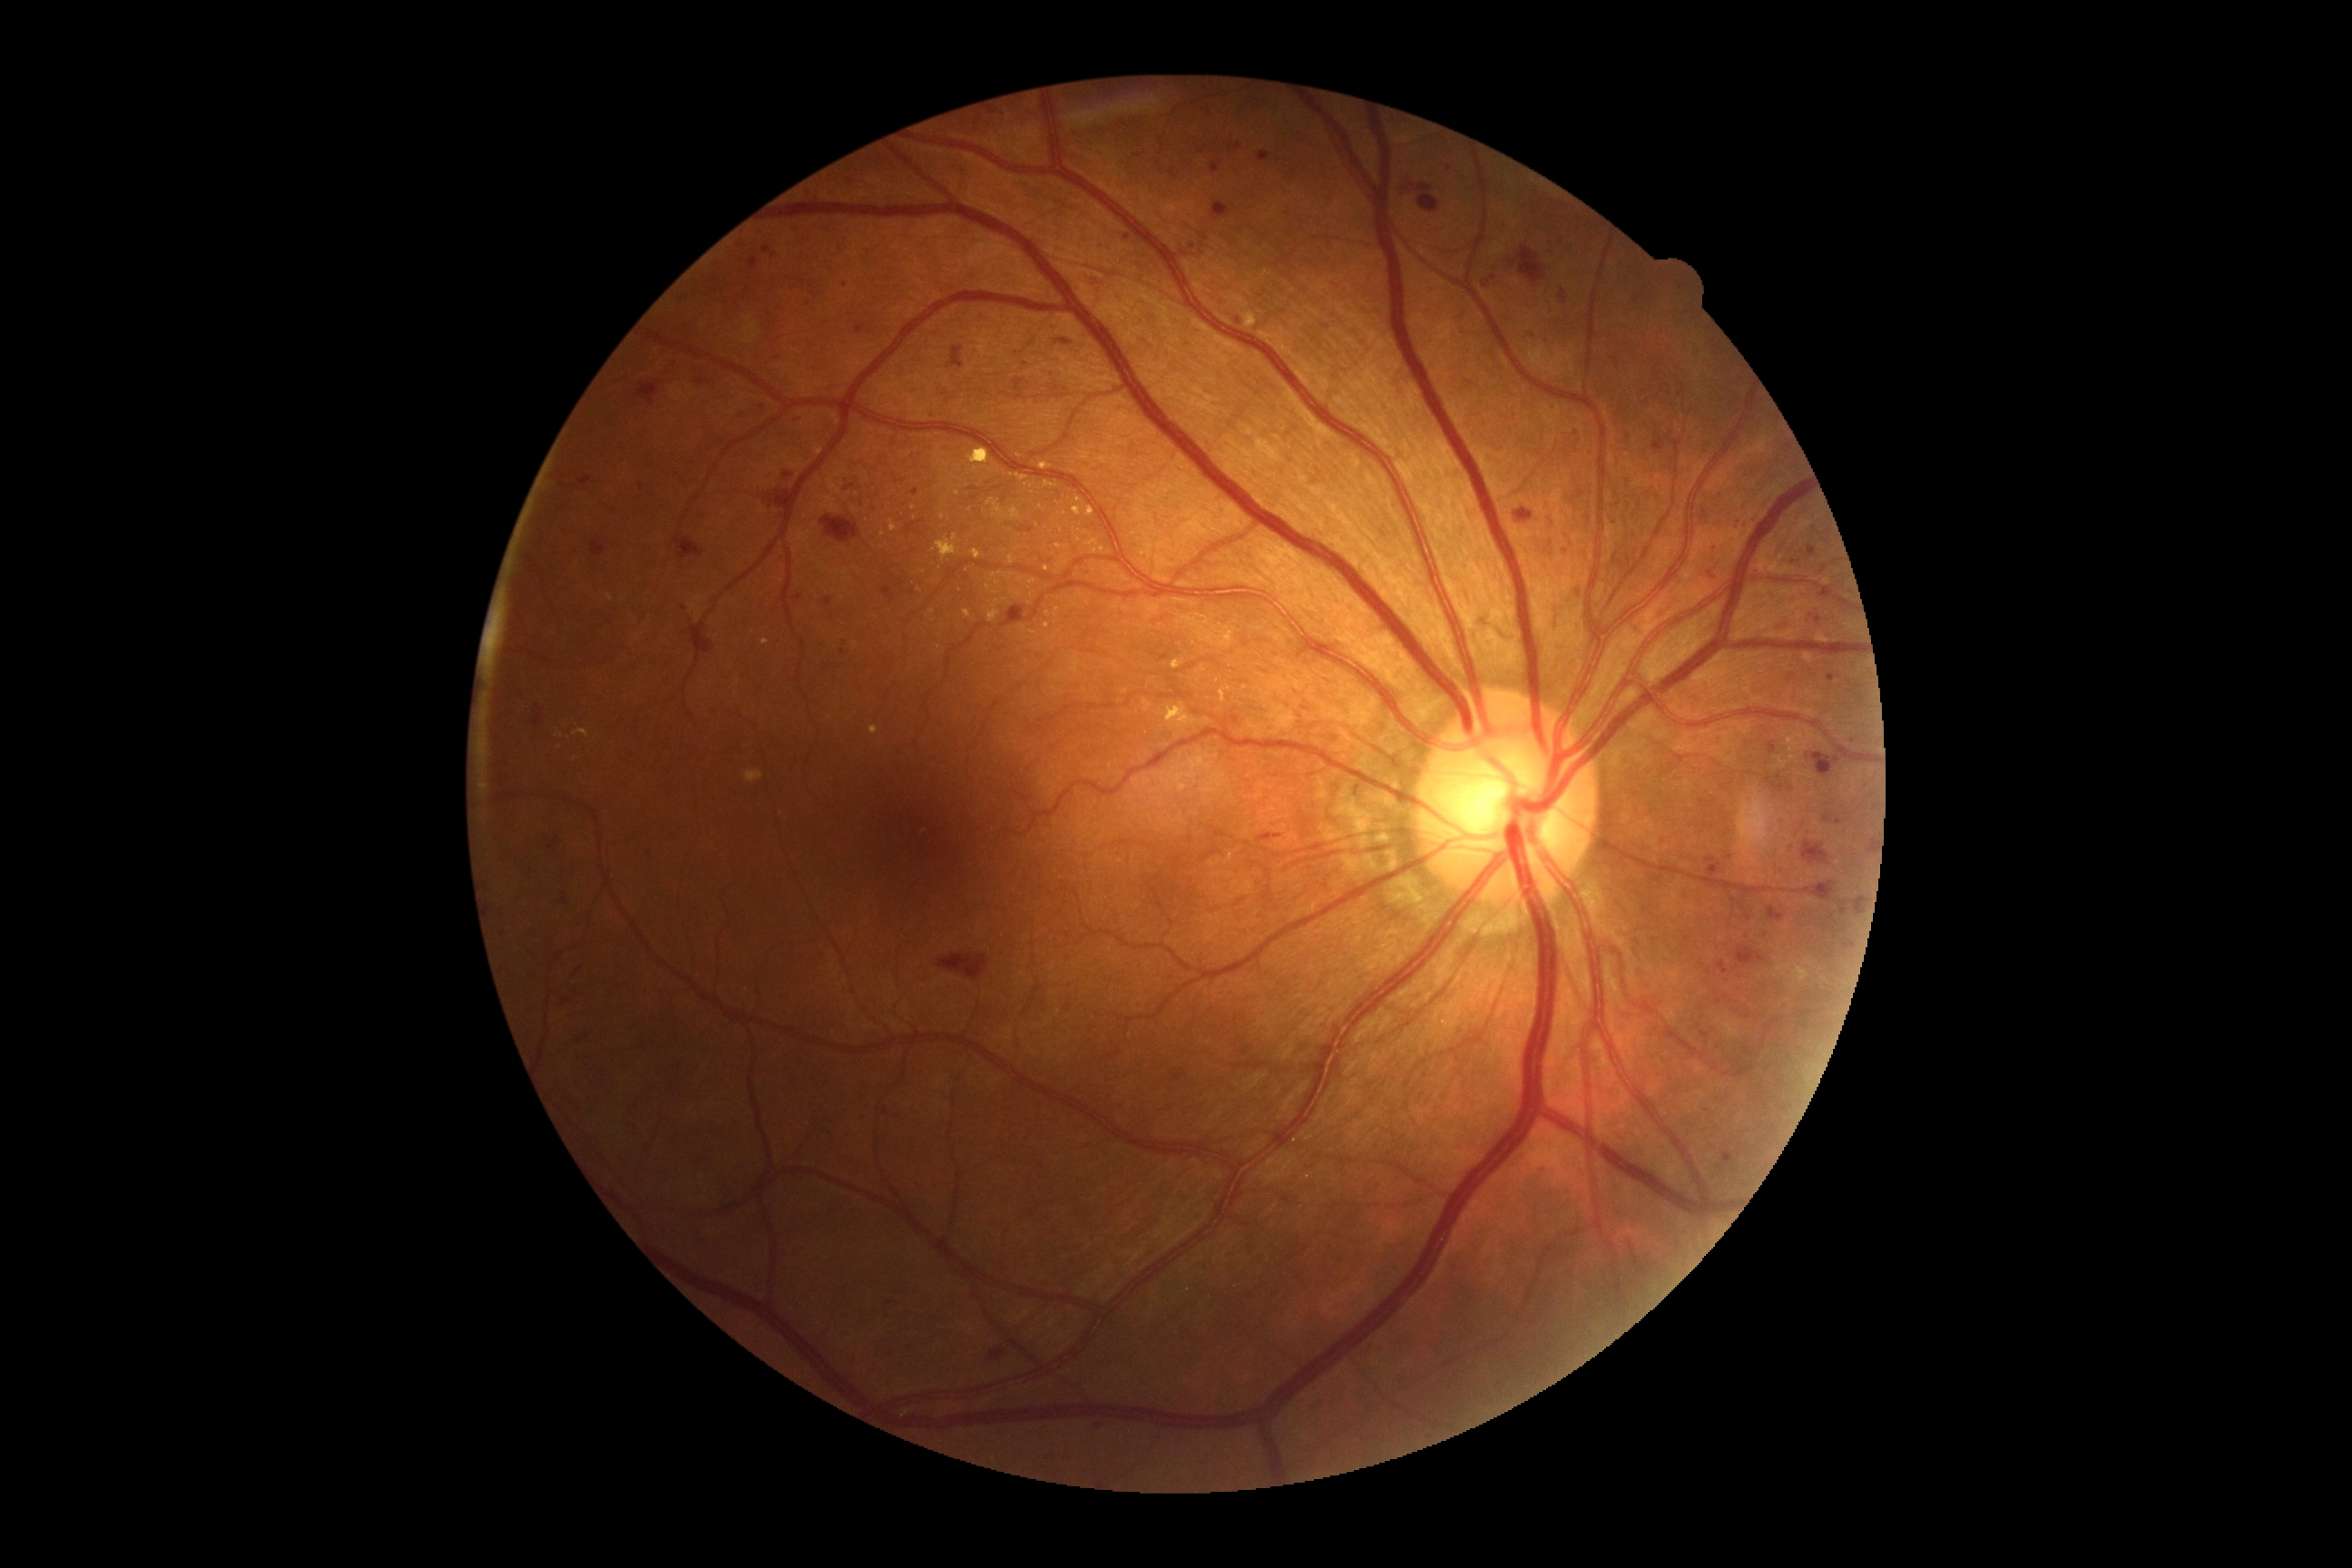 {"partial": true, "dr_grade": 2, "dr_grade_name": "moderate NPDR", "lesions": {"ex": [[972, 551, 985, 560], [986, 498, 1023, 520], [1075, 498, 1083, 504], [890, 520, 897, 533], [1057, 545, 1070, 551], [1010, 591, 1021, 596], [963, 611, 972, 618], [573, 729, 589, 740], [1222, 627, 1237, 647], [937, 534, 959, 562], [1171, 660, 1184, 671], [556, 736, 564, 740], [816, 447, 825, 456], [747, 770, 763, 783]], "ex_small_centers": [[576, 760], [997, 601], [1031, 582], [988, 588]], "ma": [[1810, 614, 1821, 625], [1827, 674, 1836, 681], [1819, 587, 1834, 600], [1124, 235, 1132, 240], [1324, 326, 1333, 329], [593, 542, 605, 558], [1718, 961, 1729, 975], [1544, 1166, 1549, 1175], [1560, 289, 1567, 304], [1856, 899, 1861, 912]], "ma_small_centers": [[1194, 247], [1738, 522], [1288, 215], [1718, 1002], [767, 475], [685, 609], [565, 899]], "he": [[1819, 910, 1839, 936], [1769, 906, 1785, 923], [636, 382, 660, 406], [1734, 946, 1767, 970], [765, 491, 794, 520], [1061, 338, 1070, 346], [990, 1349, 1006, 1360], [1514, 509, 1534, 524], [1803, 841, 1832, 867], [950, 348, 965, 369], [1507, 248, 1545, 284], [689, 623, 714, 667]], "he_small_centers": [[701, 383]]}}